Color fundus photograph:
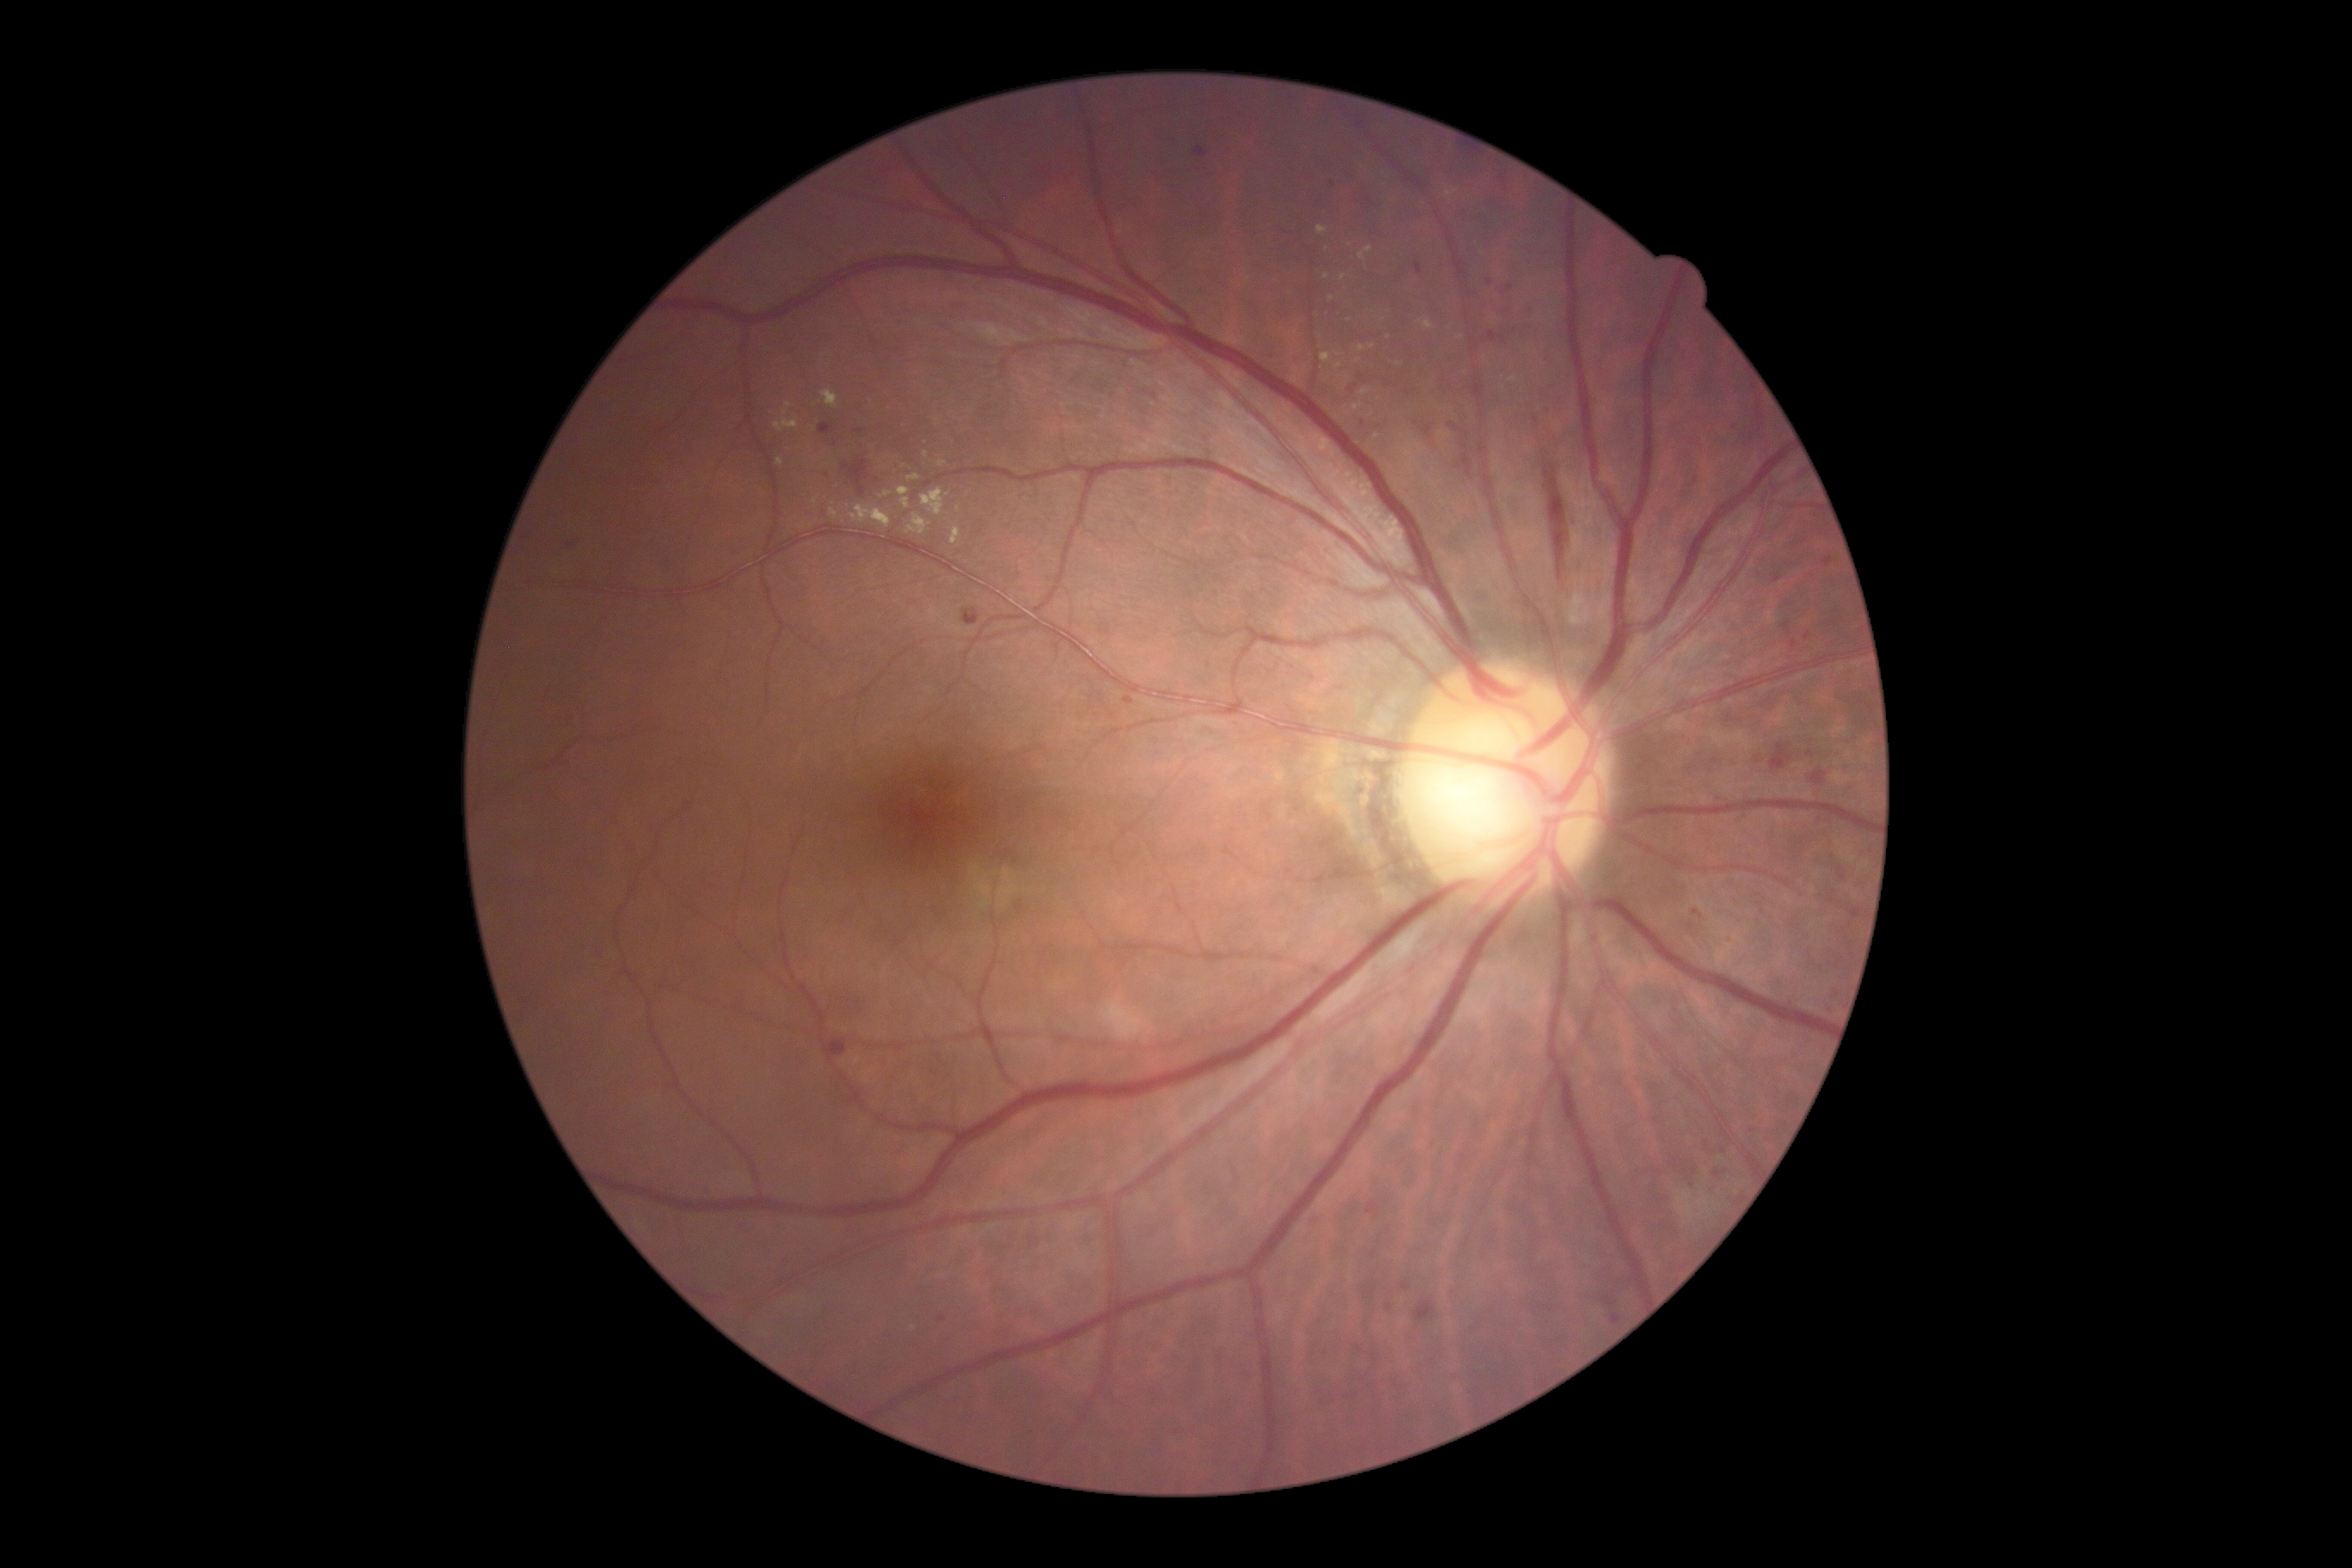
DR: grade 2 (moderate NPDR) | DR class: non-proliferative diabetic retinopathy.